45-degree field of view; 2212 x 1659 pixels.
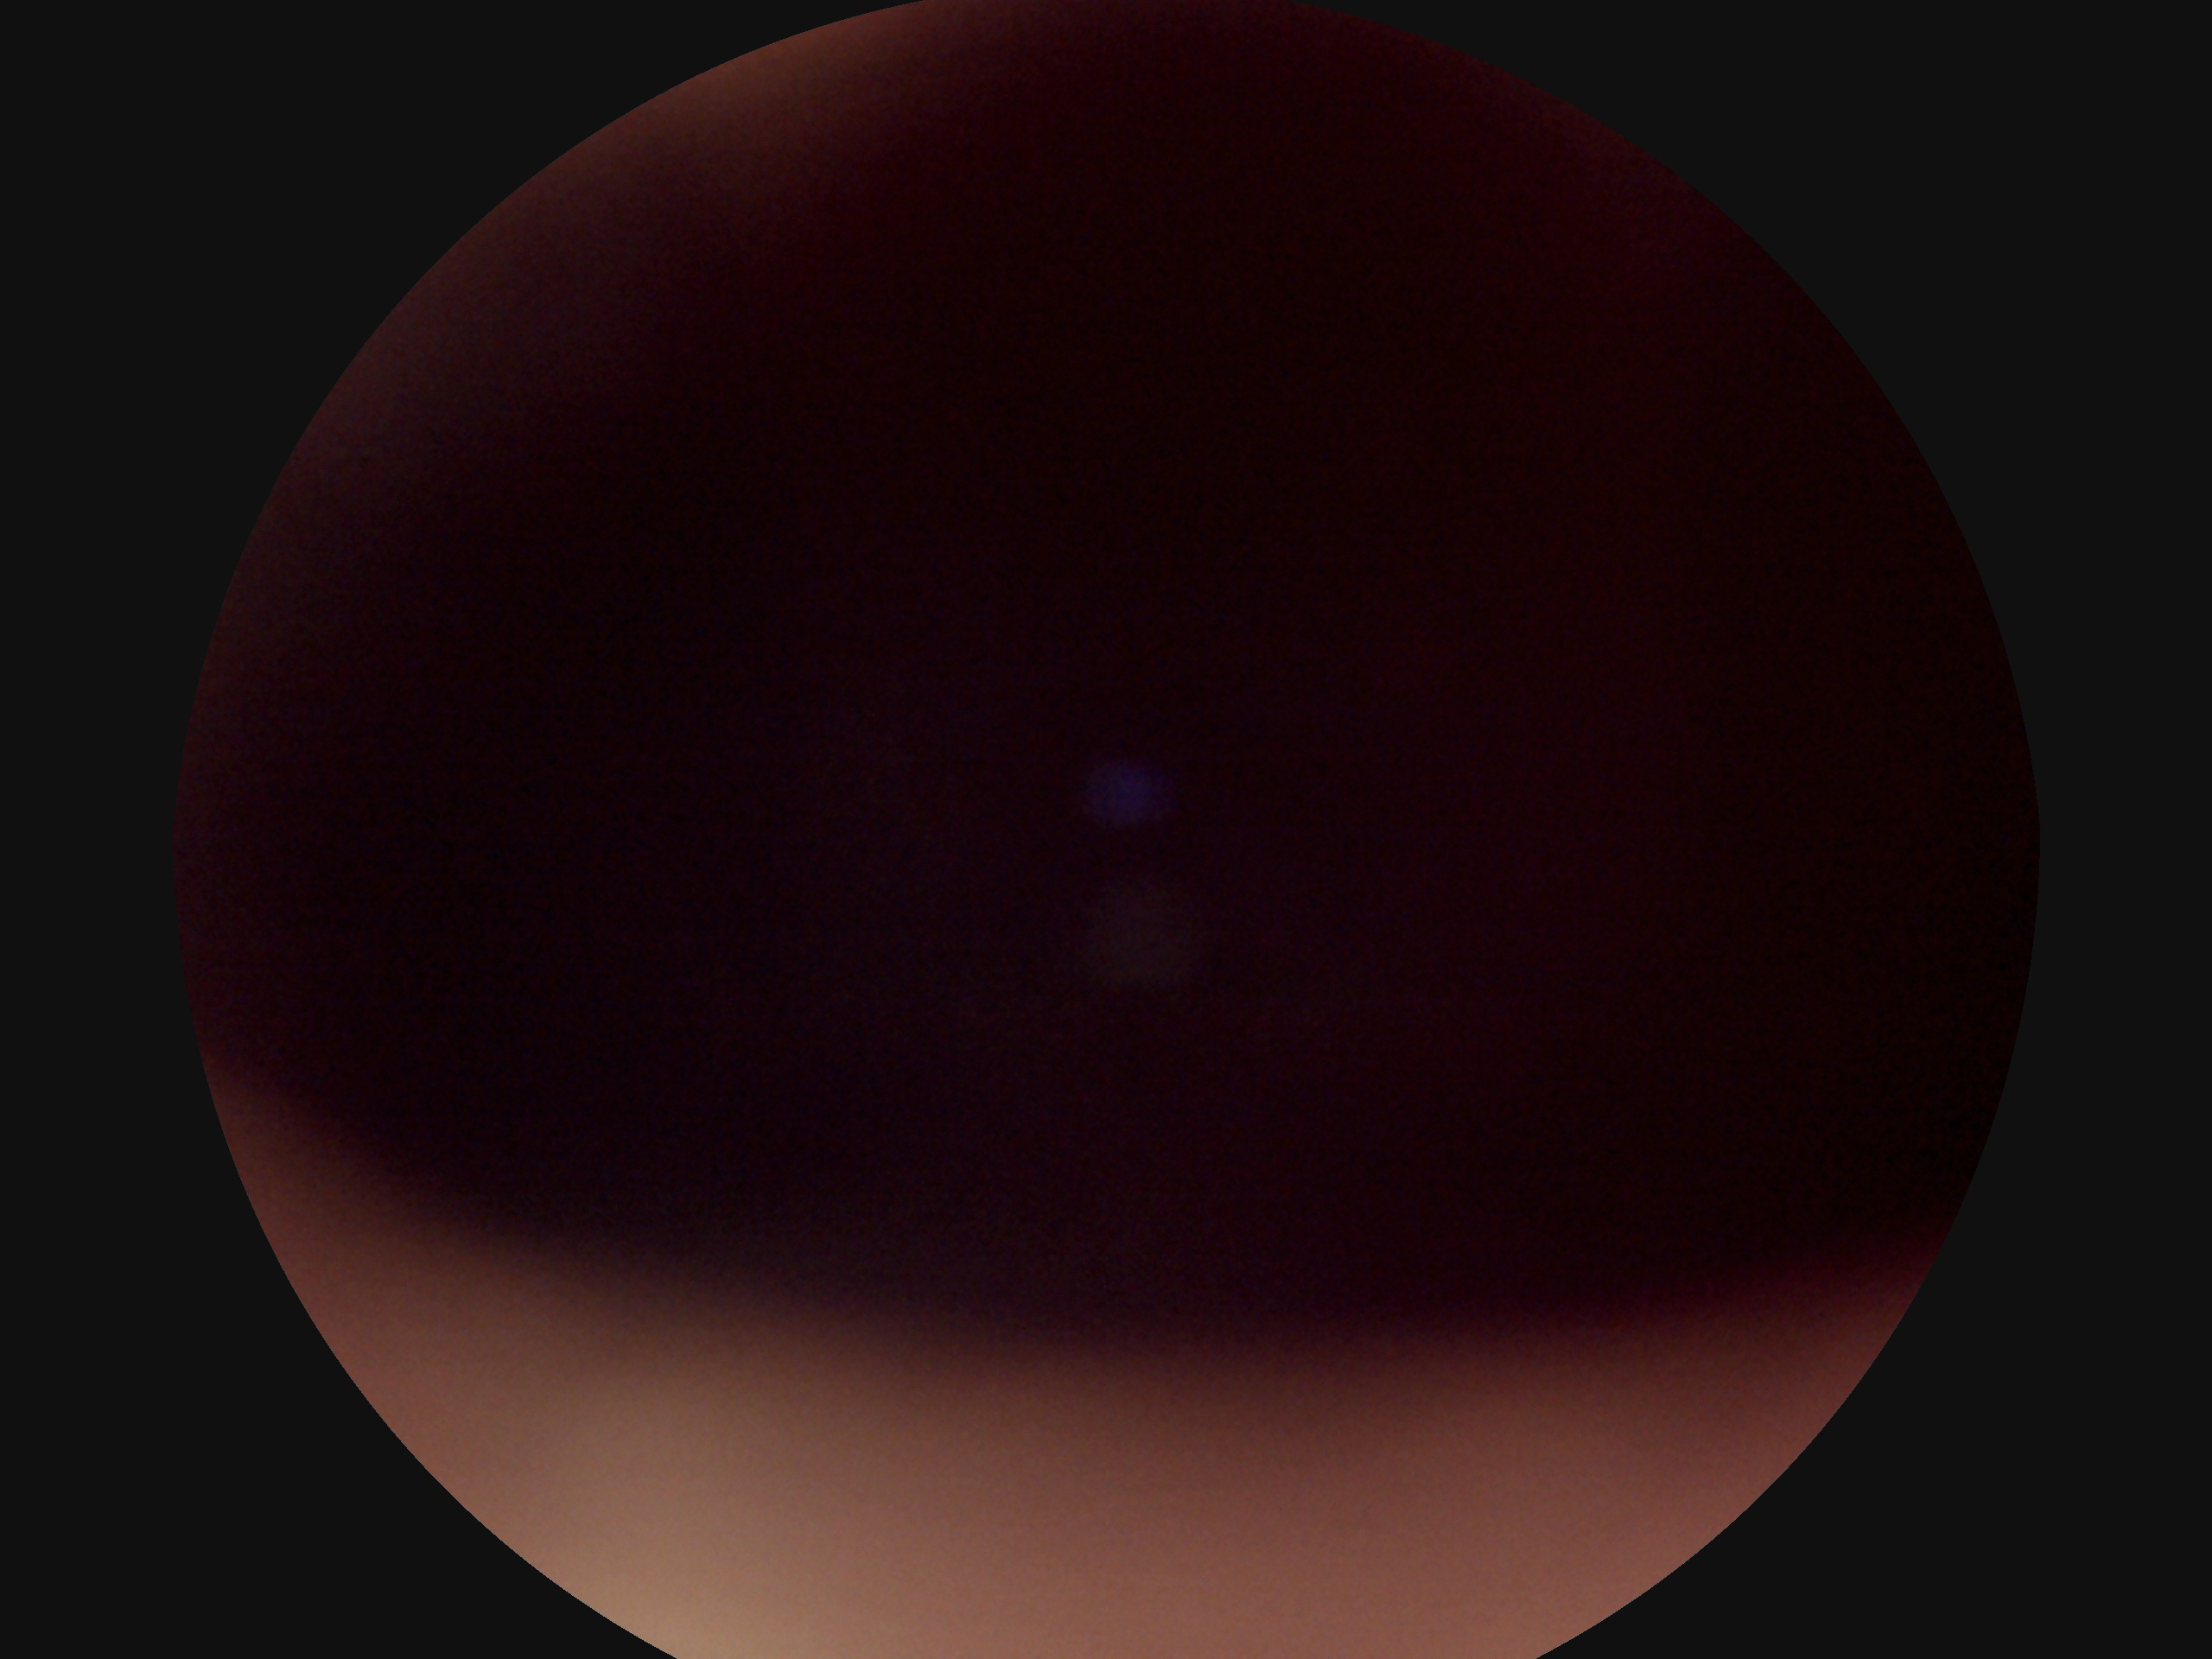

DR: ungradable due to poor image quality.